Image size 1932x1910, CFP, 45-degree field of view
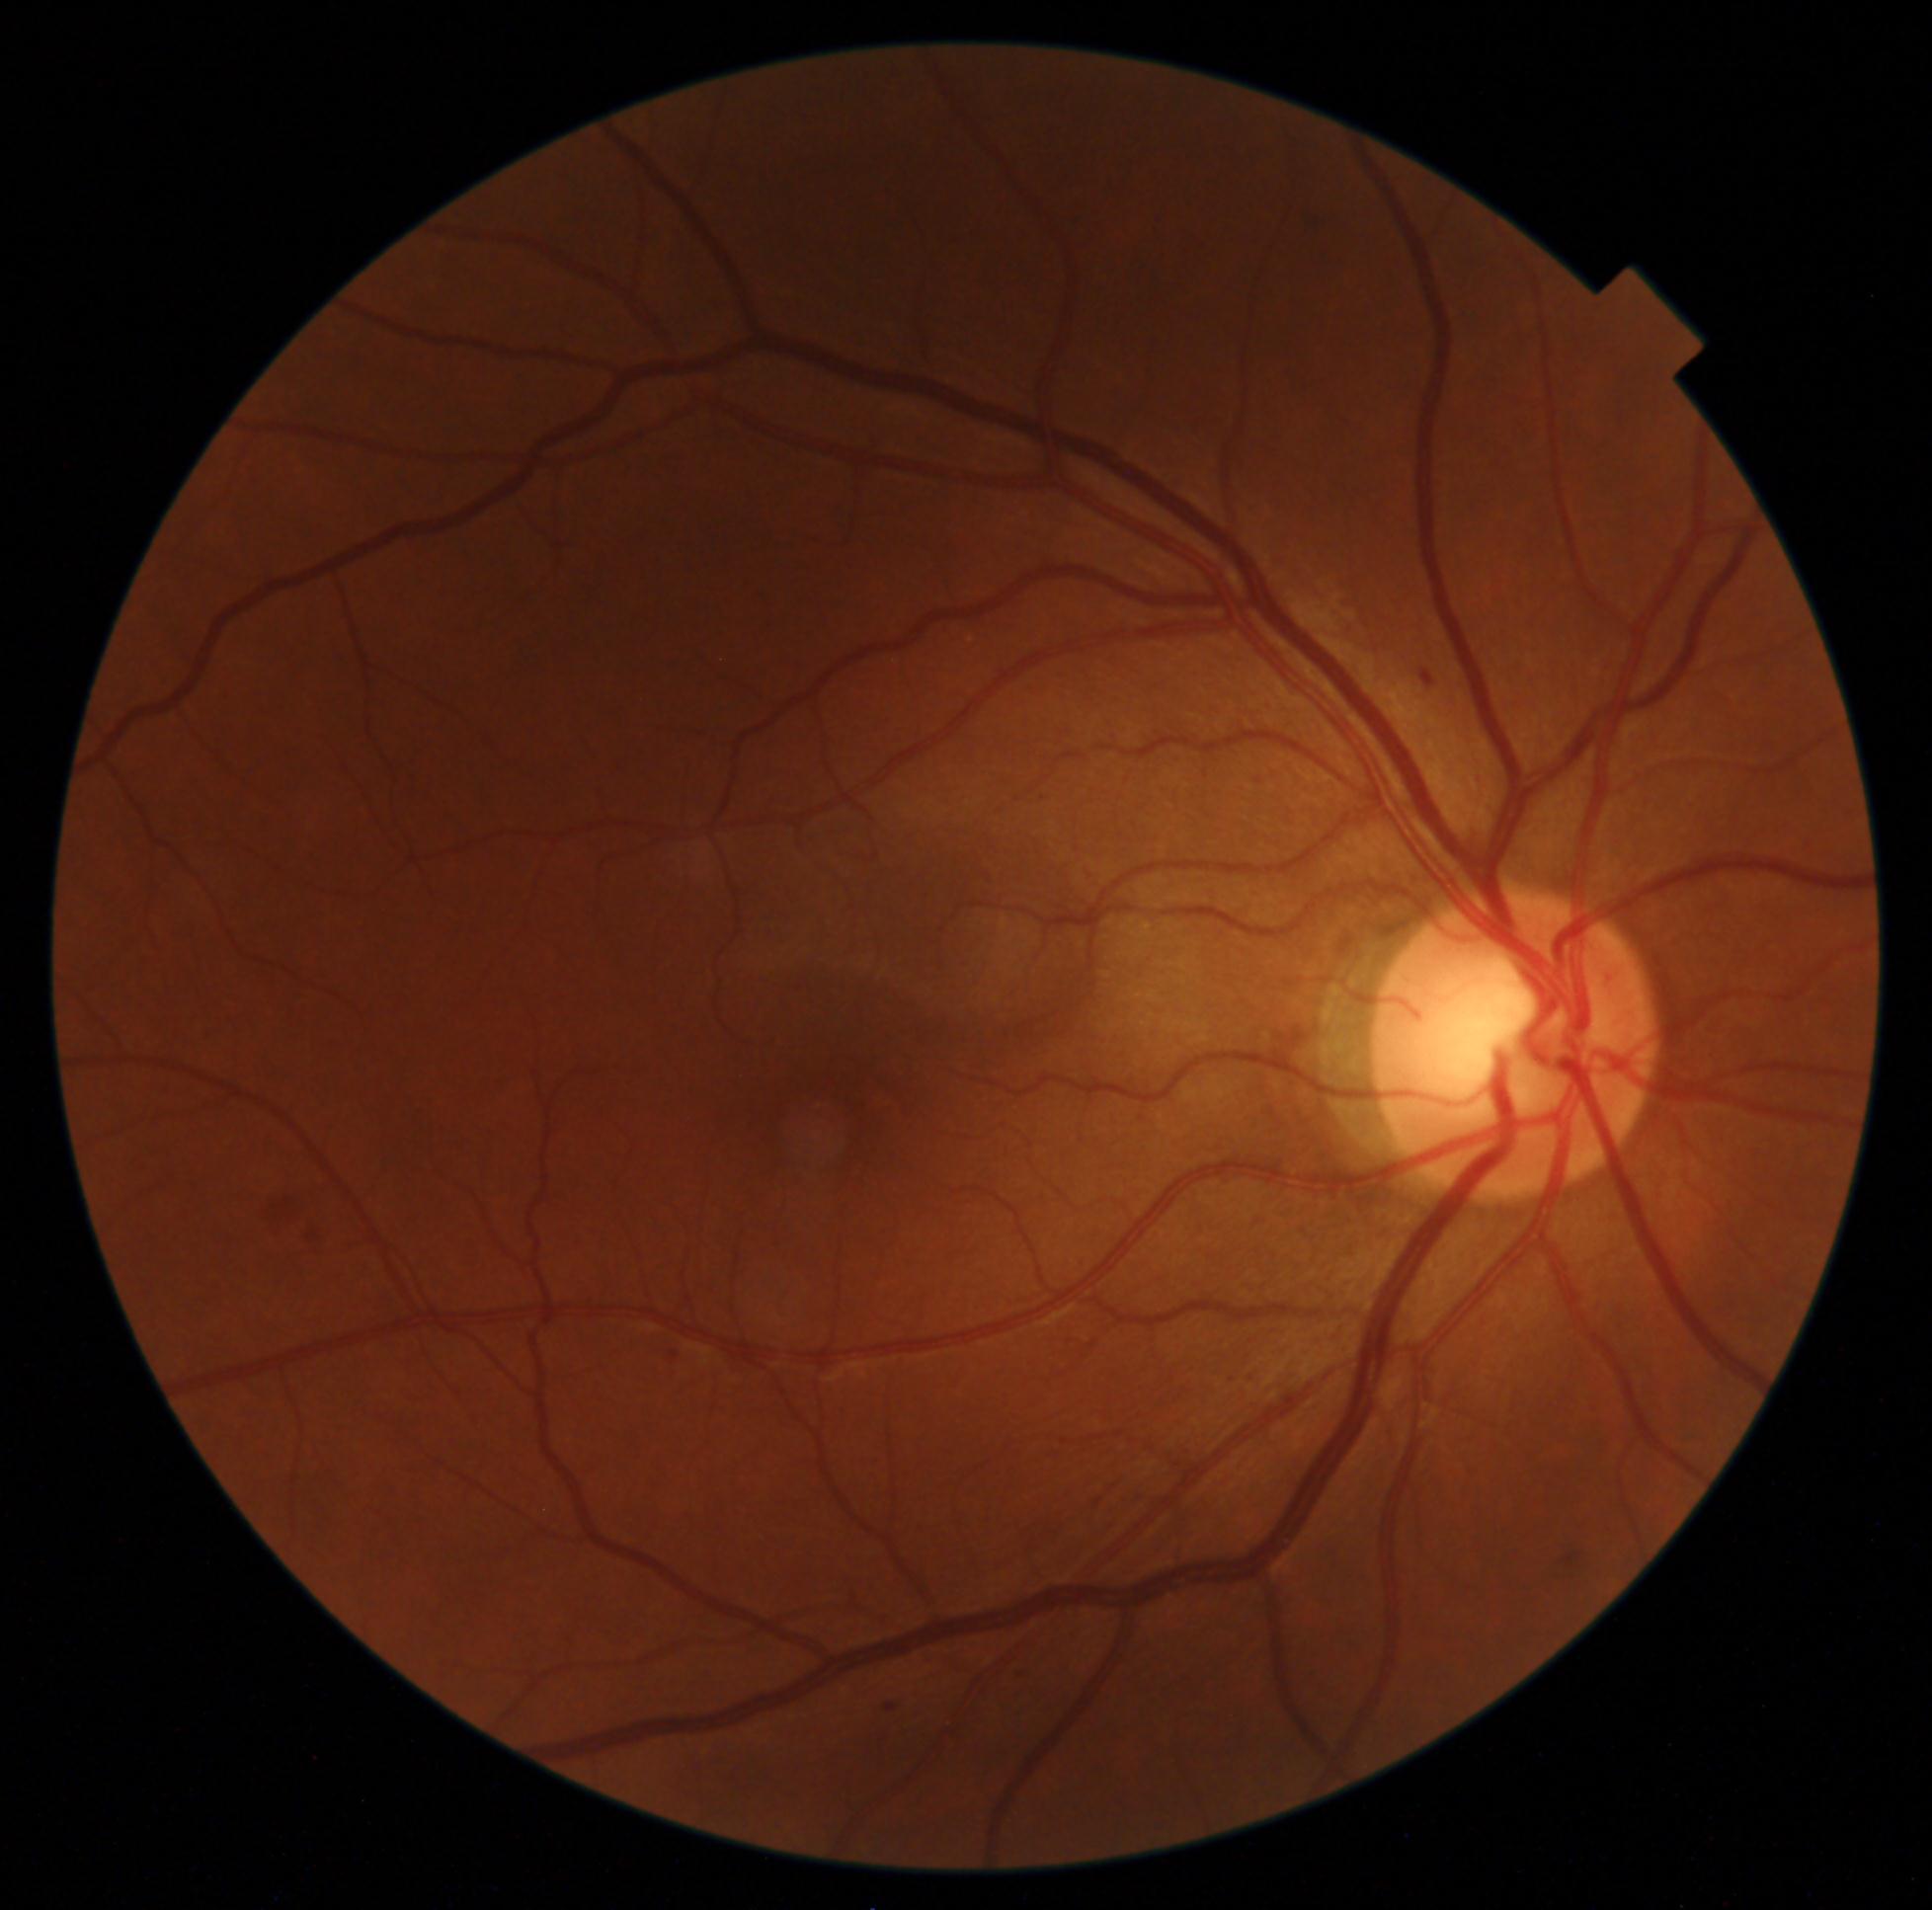   dr_grade: 2
  dr_category: non-proliferative diabetic retinopathy